45° FOV, DR severity per modified Davis staging.
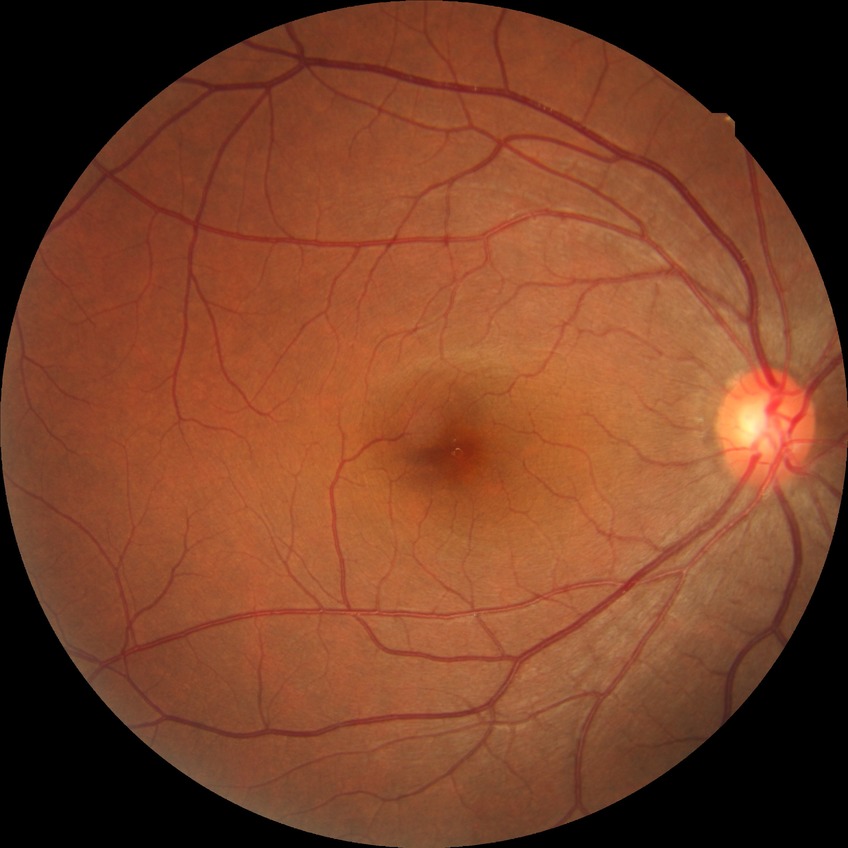 Diabetic retinopathy (DR) is NDR (no diabetic retinopathy).